1932 x 1932 pixels.
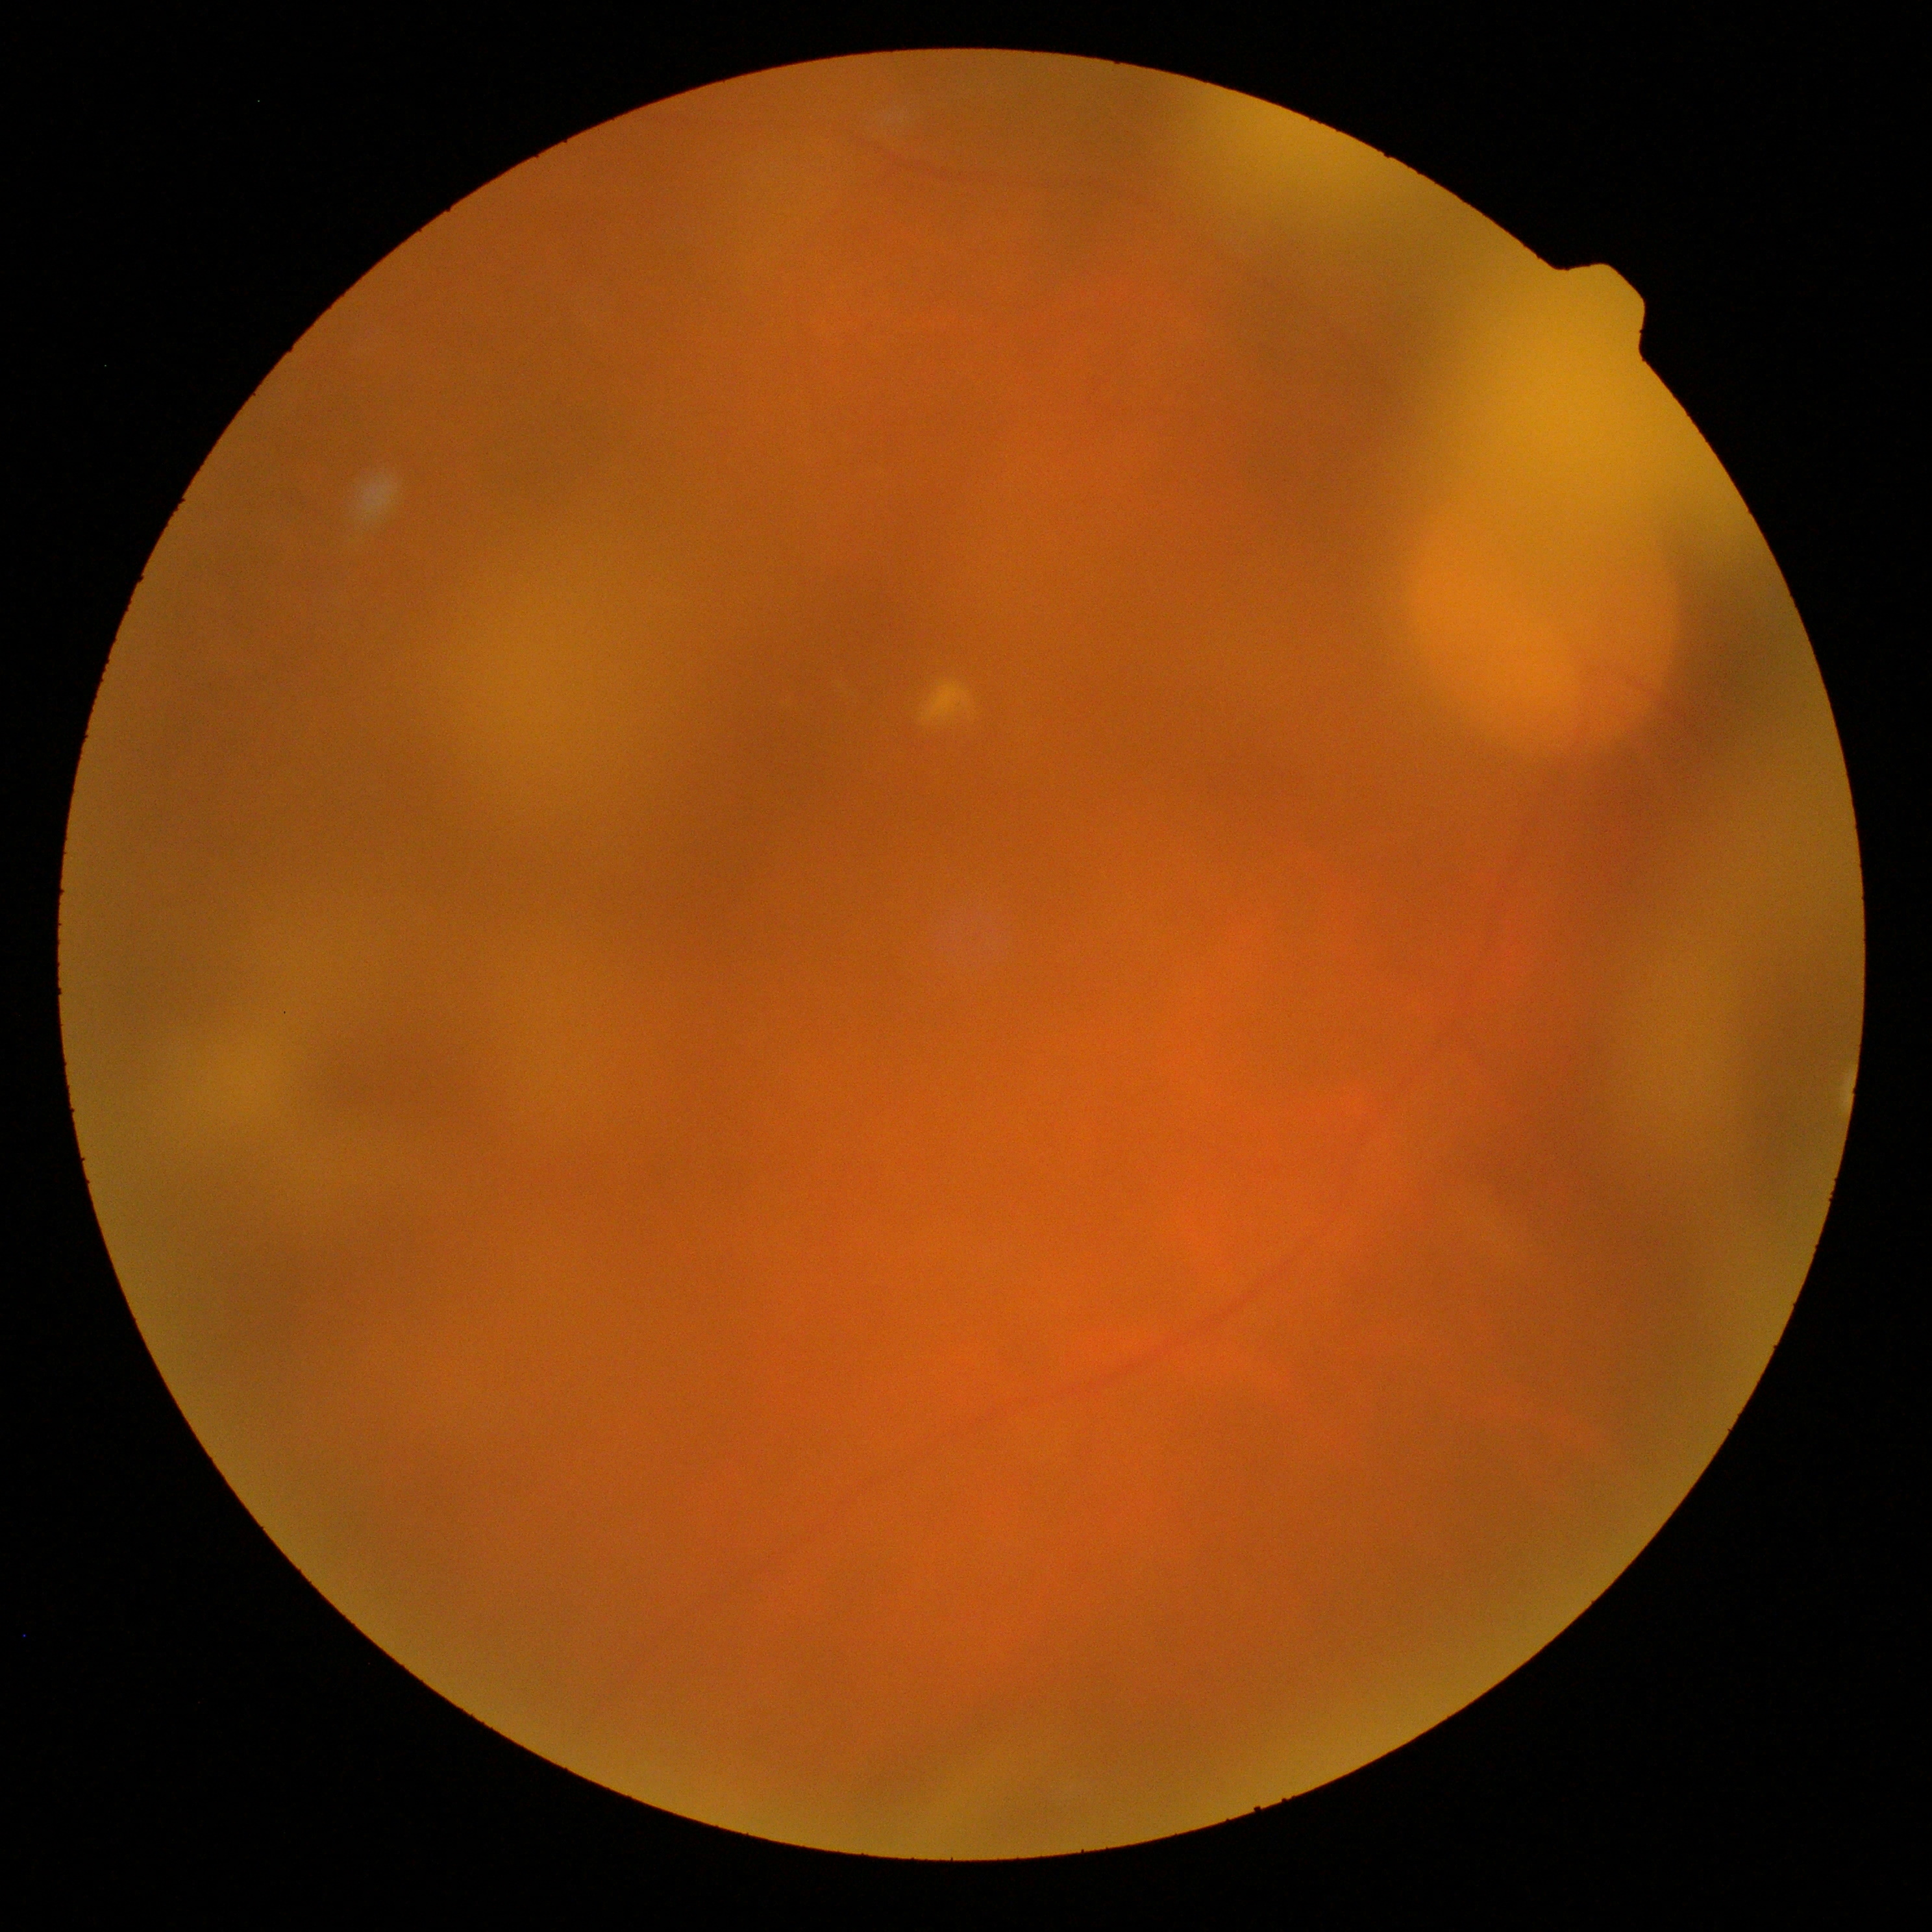 DR: ungradable due to poor image quality; image quality: too poor for DR grading.